Modified Davis grading — 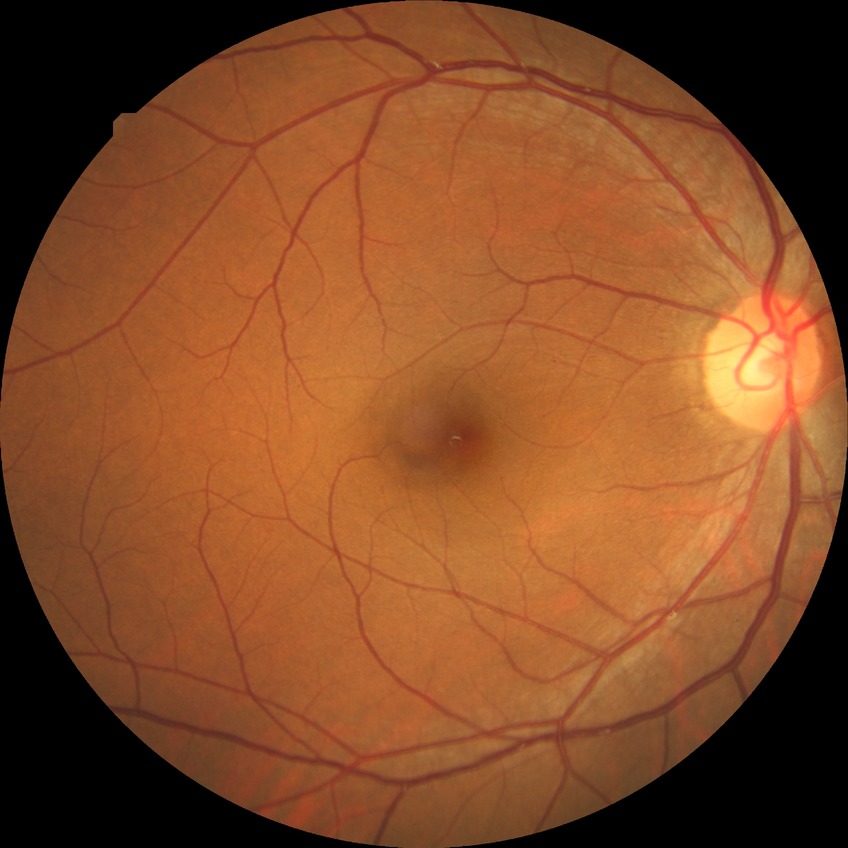

Davis stage: NDR.